Retinal fundus photograph: 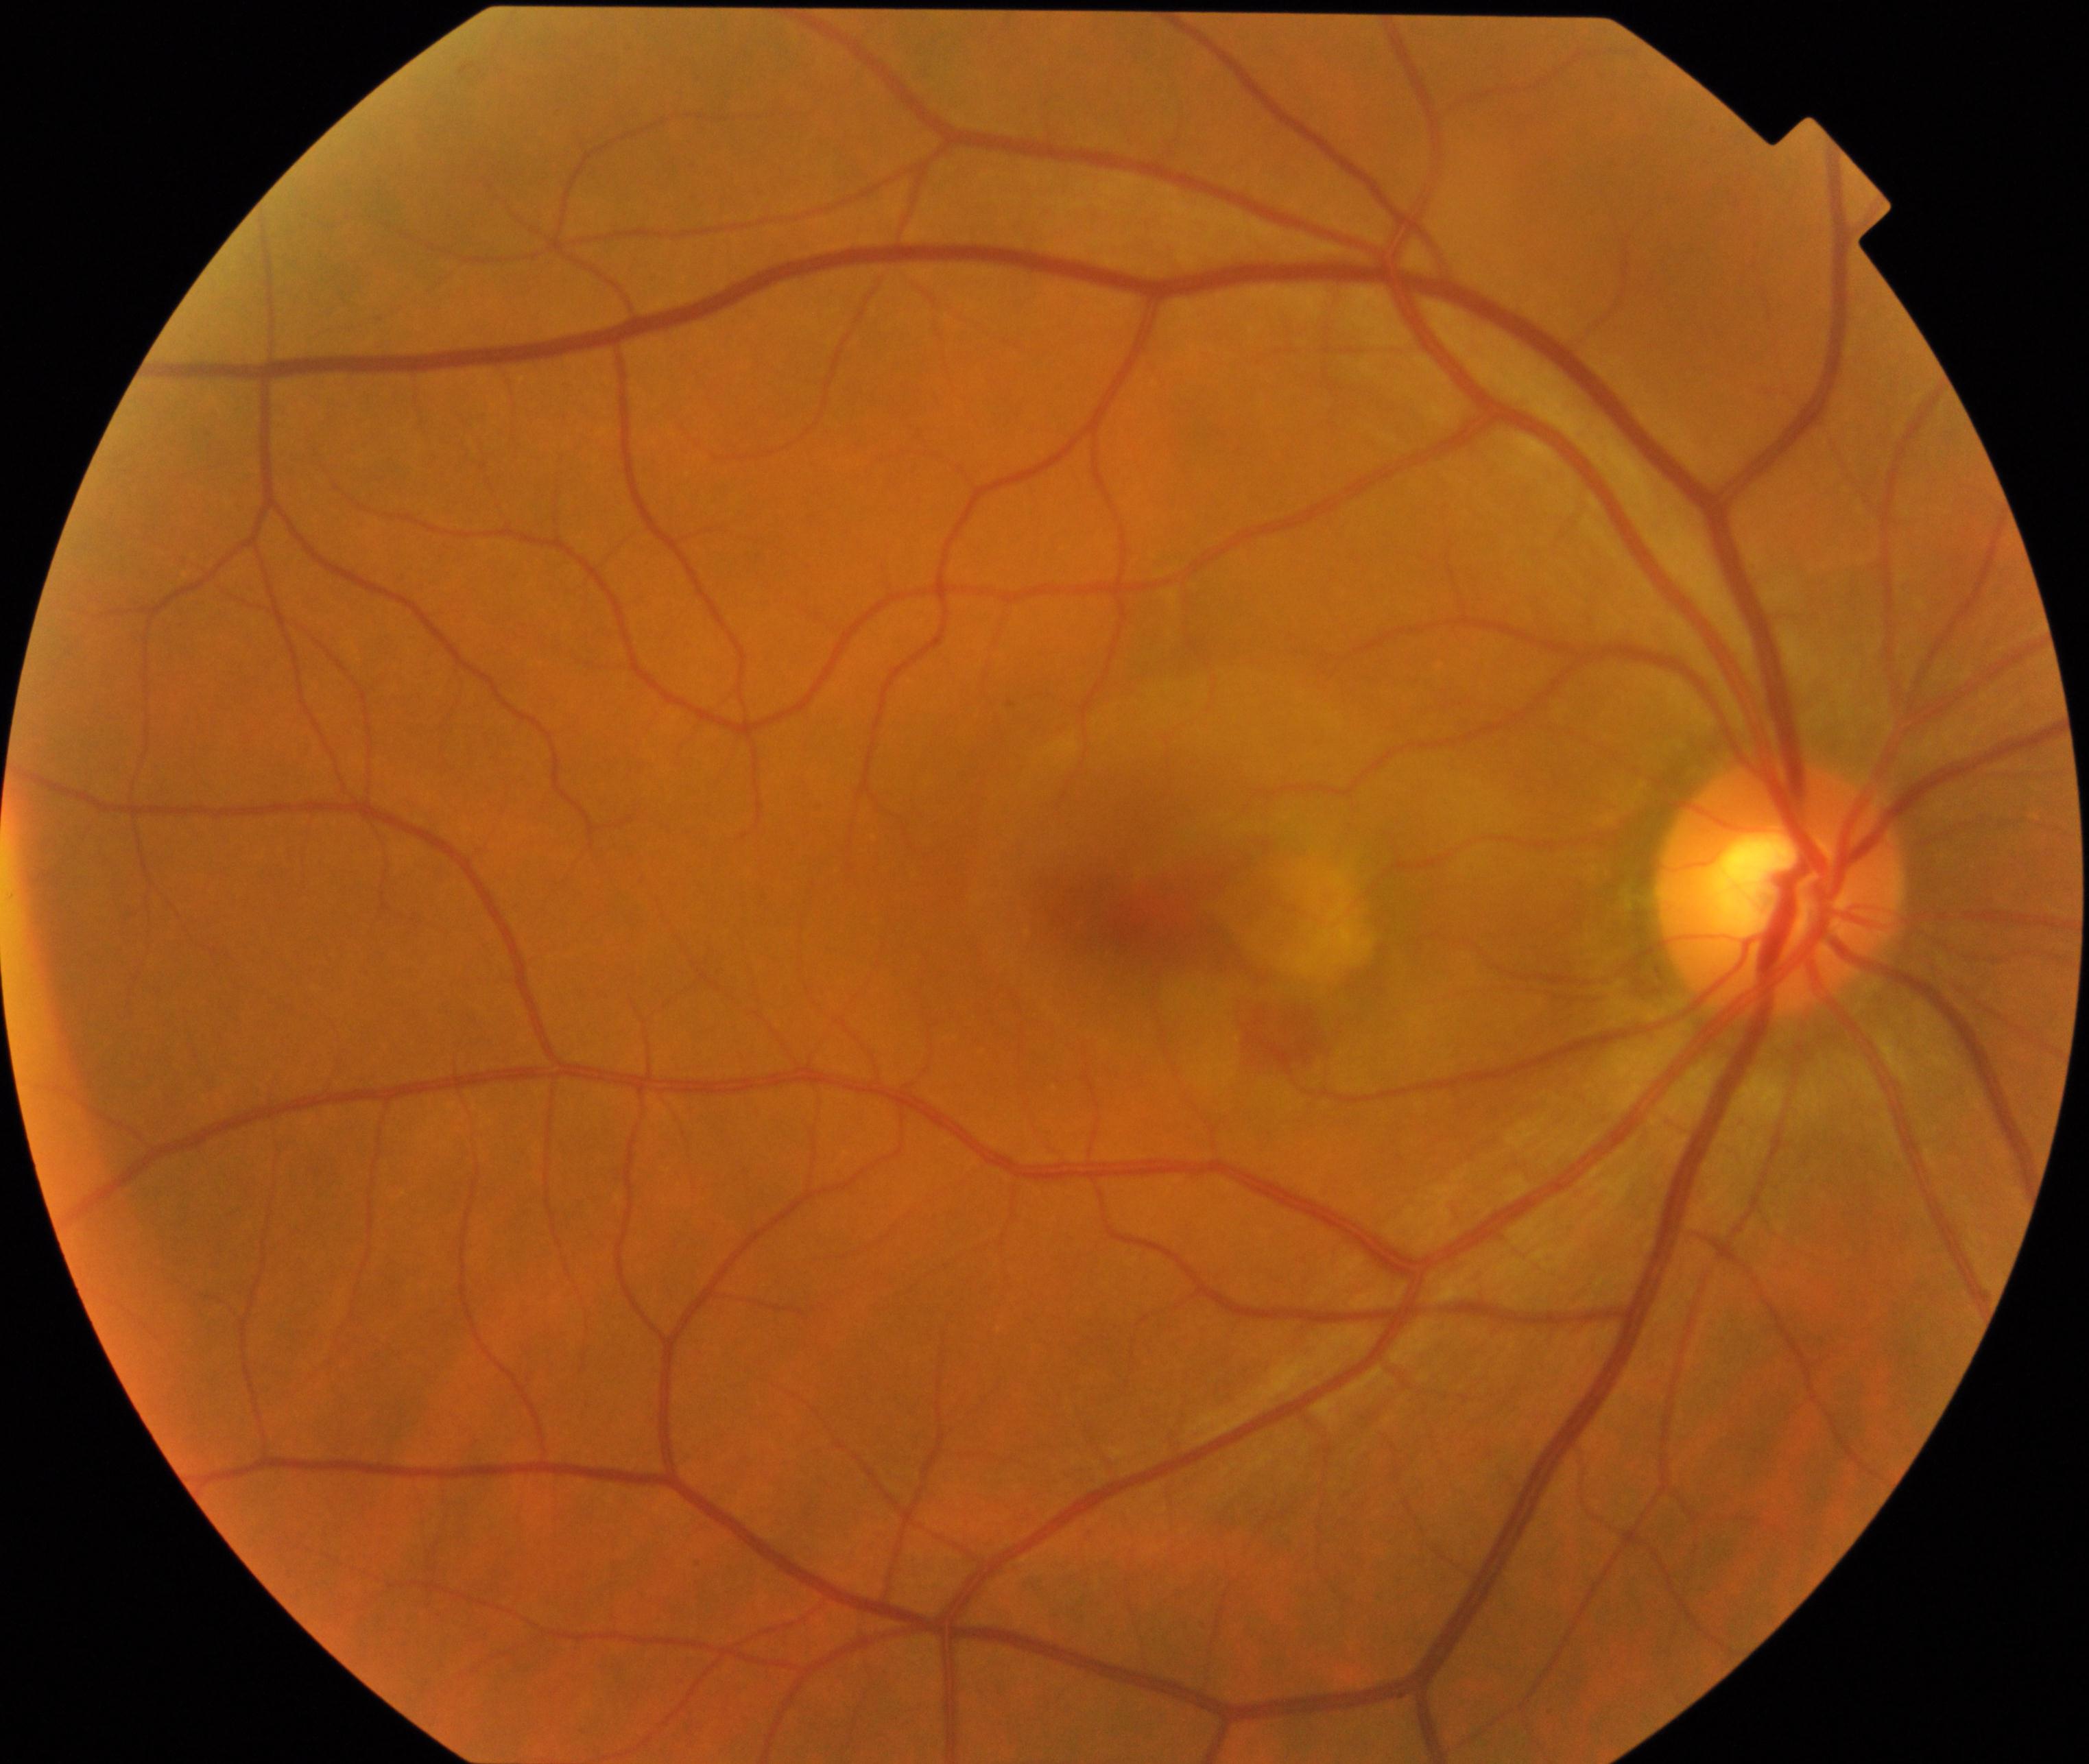
Findings: maculopathy.